Wide-field contact fundus photograph of an infant.
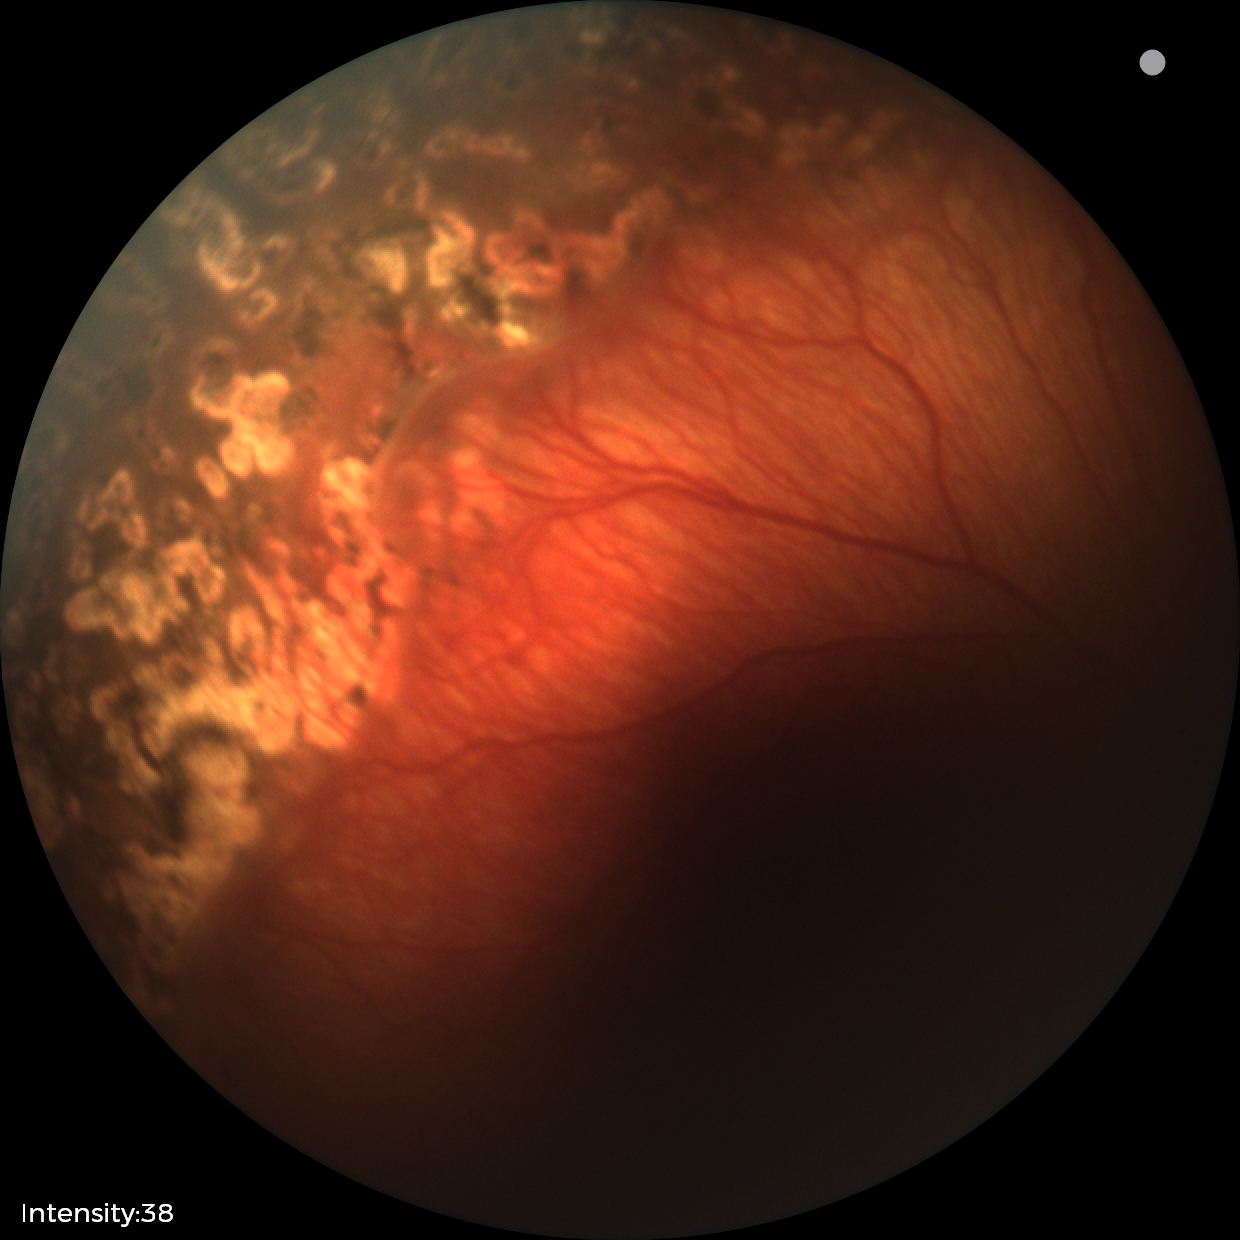 Q: What is the screening diagnosis?
A: status post ROP — retinal appearance after treated retinopathy of prematurity